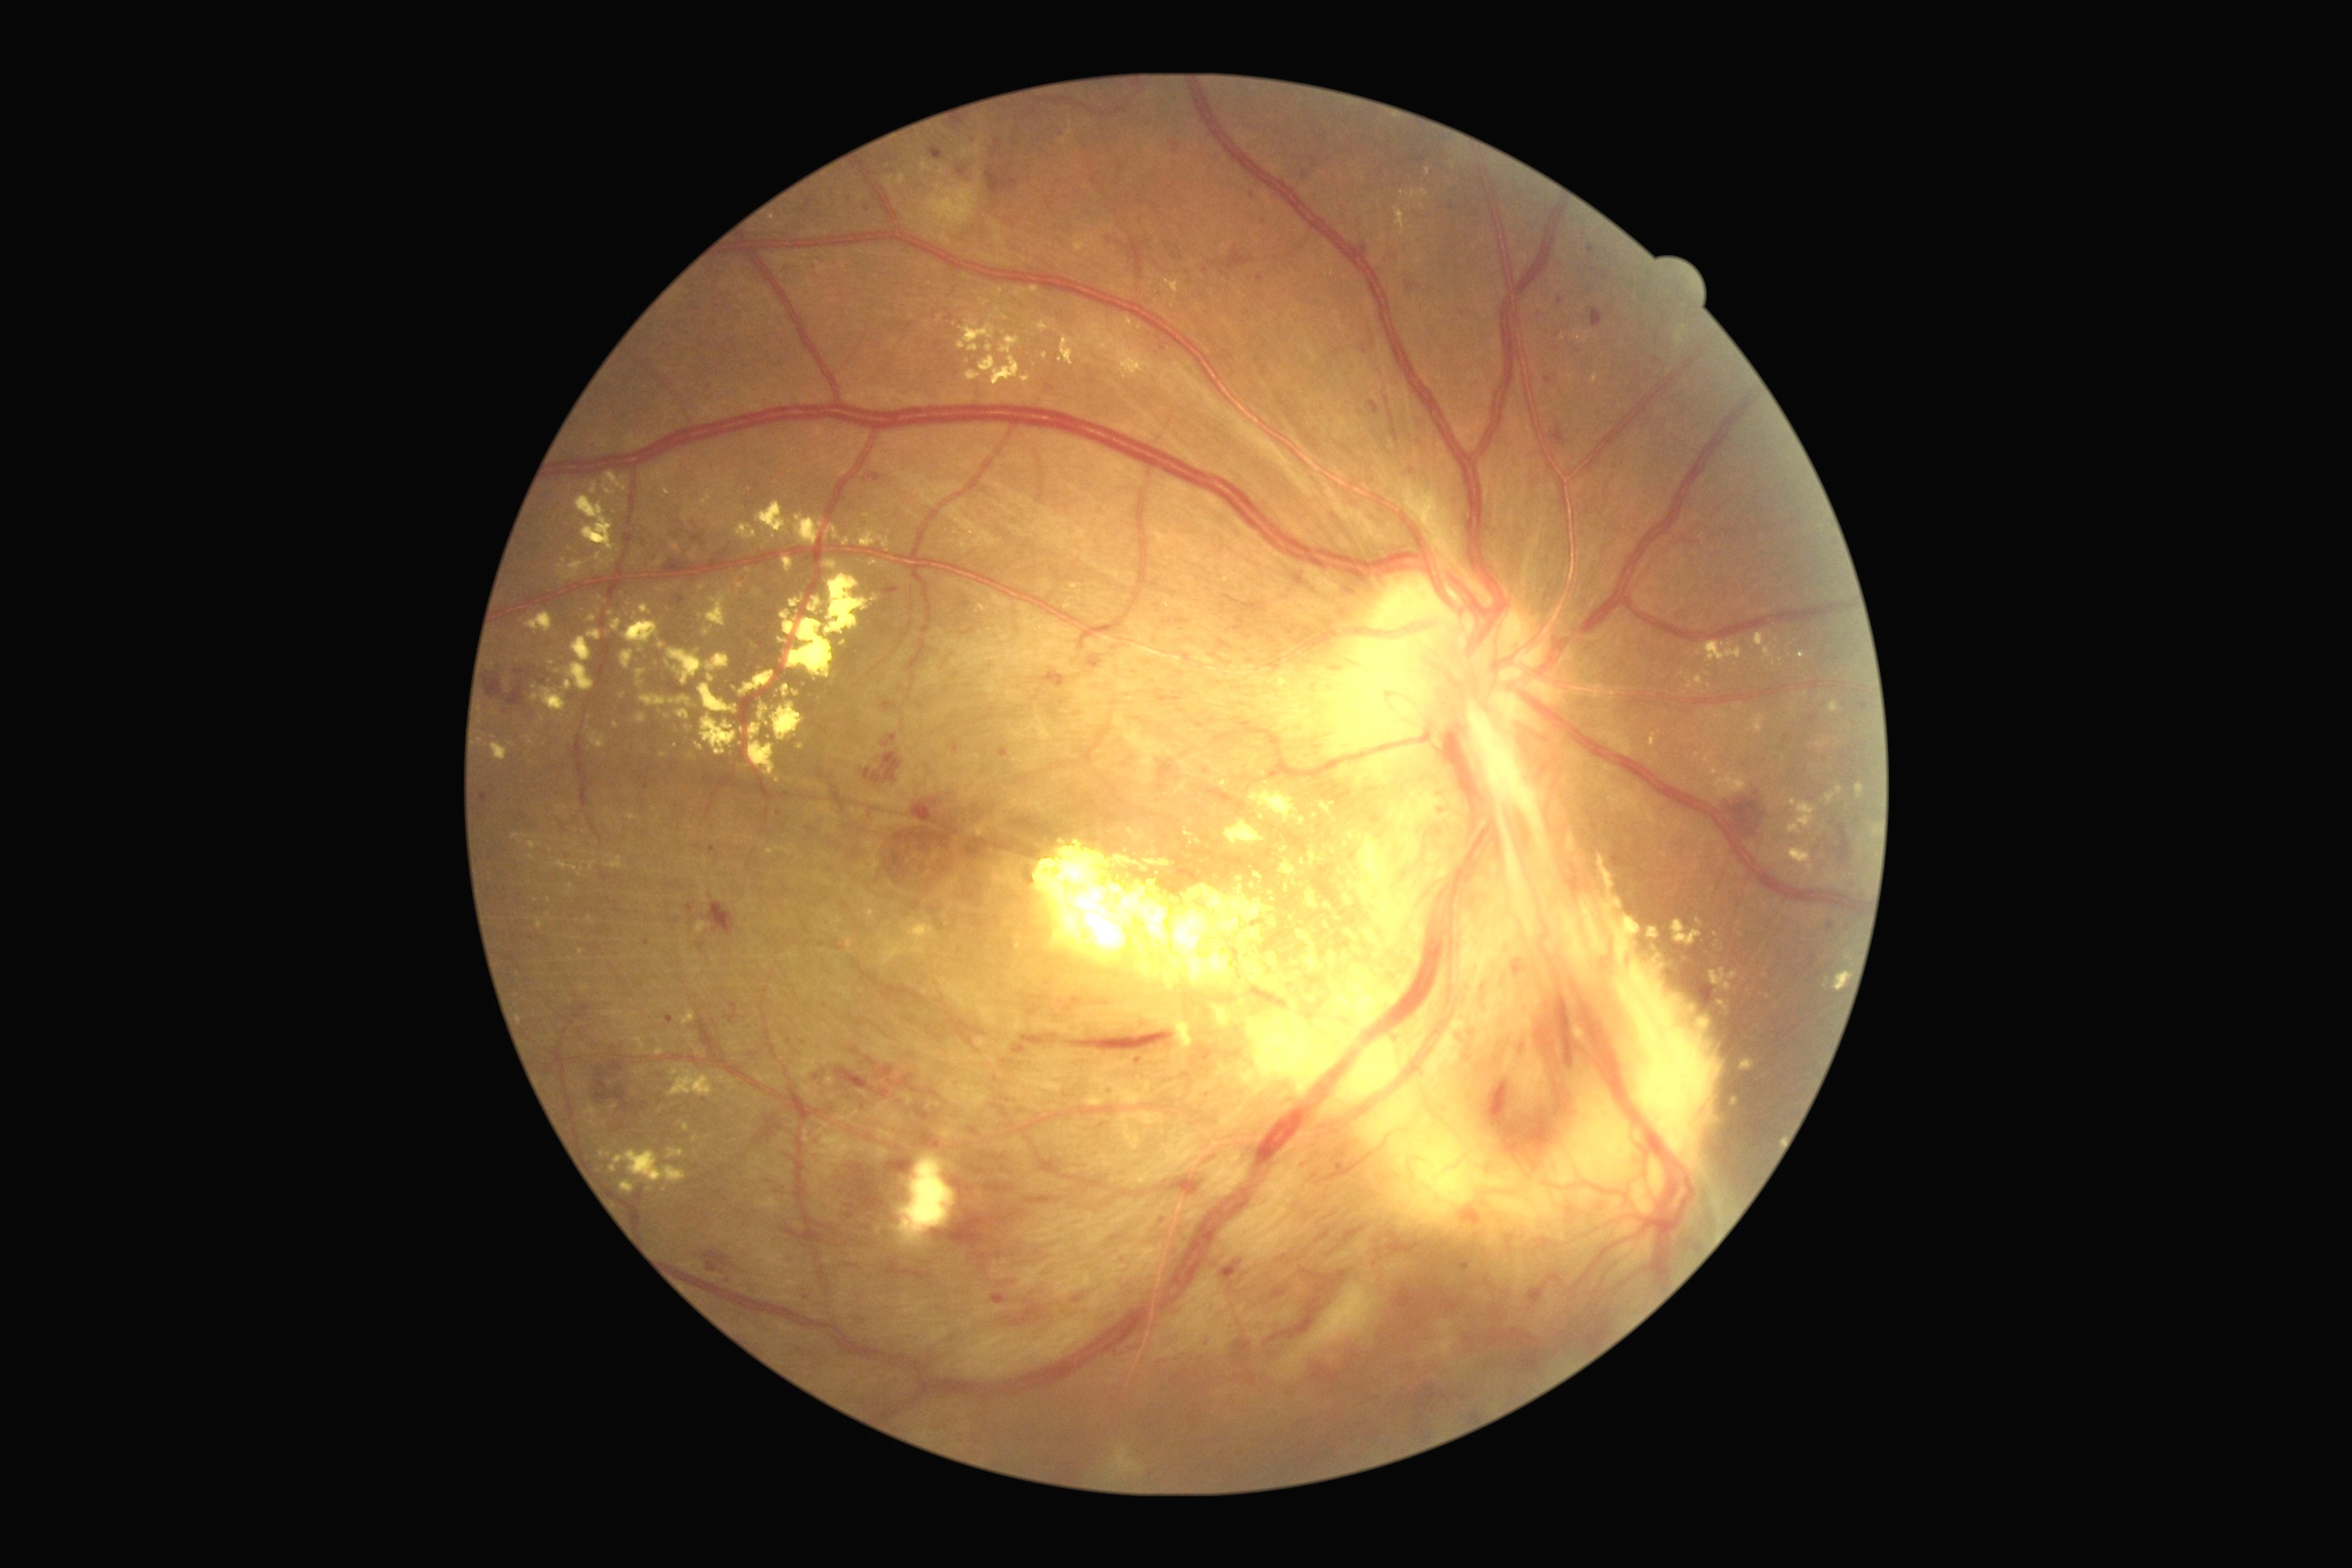

<lesions partial="true">
  <dr_grade>4</dr_grade>
  <ex partial="true">[x1=667, y1=1148, x2=685, y2=1161], [x1=1727, y1=1097, x2=1740, y2=1112], [x1=1818, y1=743, x2=1827, y2=747], [x1=576, y1=495, x2=618, y2=553], [x1=623, y1=622, x2=660, y2=652], [x1=594, y1=553, x2=607, y2=564], [x1=691, y1=549, x2=698, y2=562], [x1=827, y1=562, x2=838, y2=569], [x1=1217, y1=1006, x2=1235, y2=1028], [x1=511, y1=834, x2=522, y2=839], [x1=493, y1=743, x2=509, y2=761], [x1=859, y1=531, x2=890, y2=553], [x1=738, y1=740, x2=743, y2=749], [x1=671, y1=544, x2=681, y2=554]</ex>
  <ex_small_centers>point(600, 569), point(711, 679), point(1304, 886), point(564, 562), point(987, 303)</ex_small_centers>
</lesions>